45 degree fundus photograph. Nonmydriatic. Color fundus photograph. NIDEK AFC-230 — 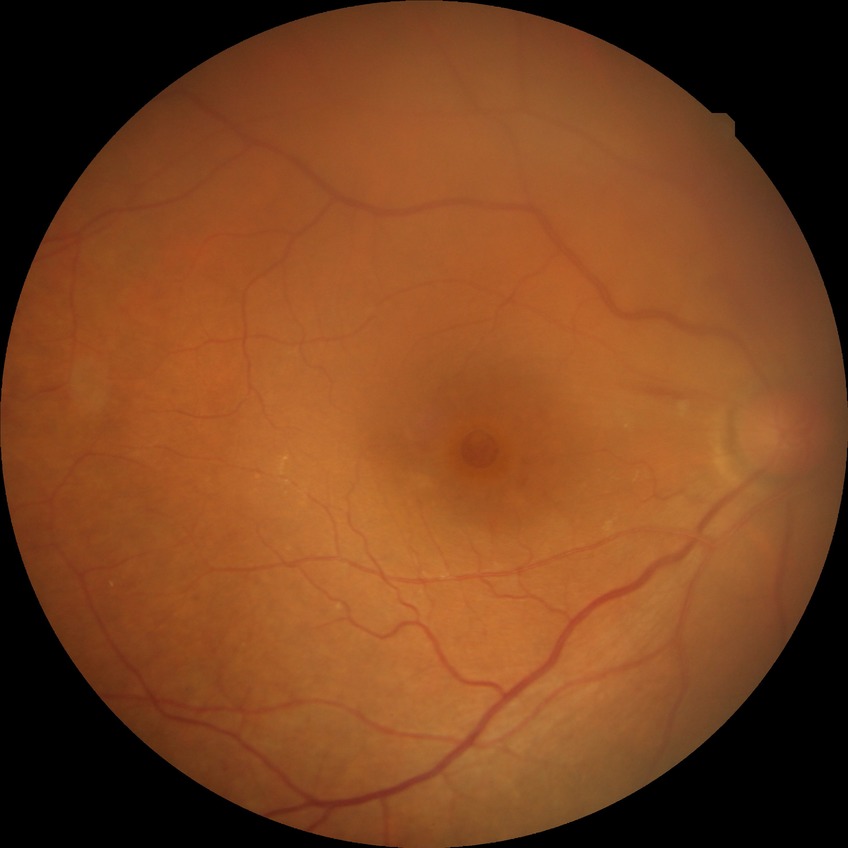
DR grade: SDR.